Image size 2346x1568; 45° FOV
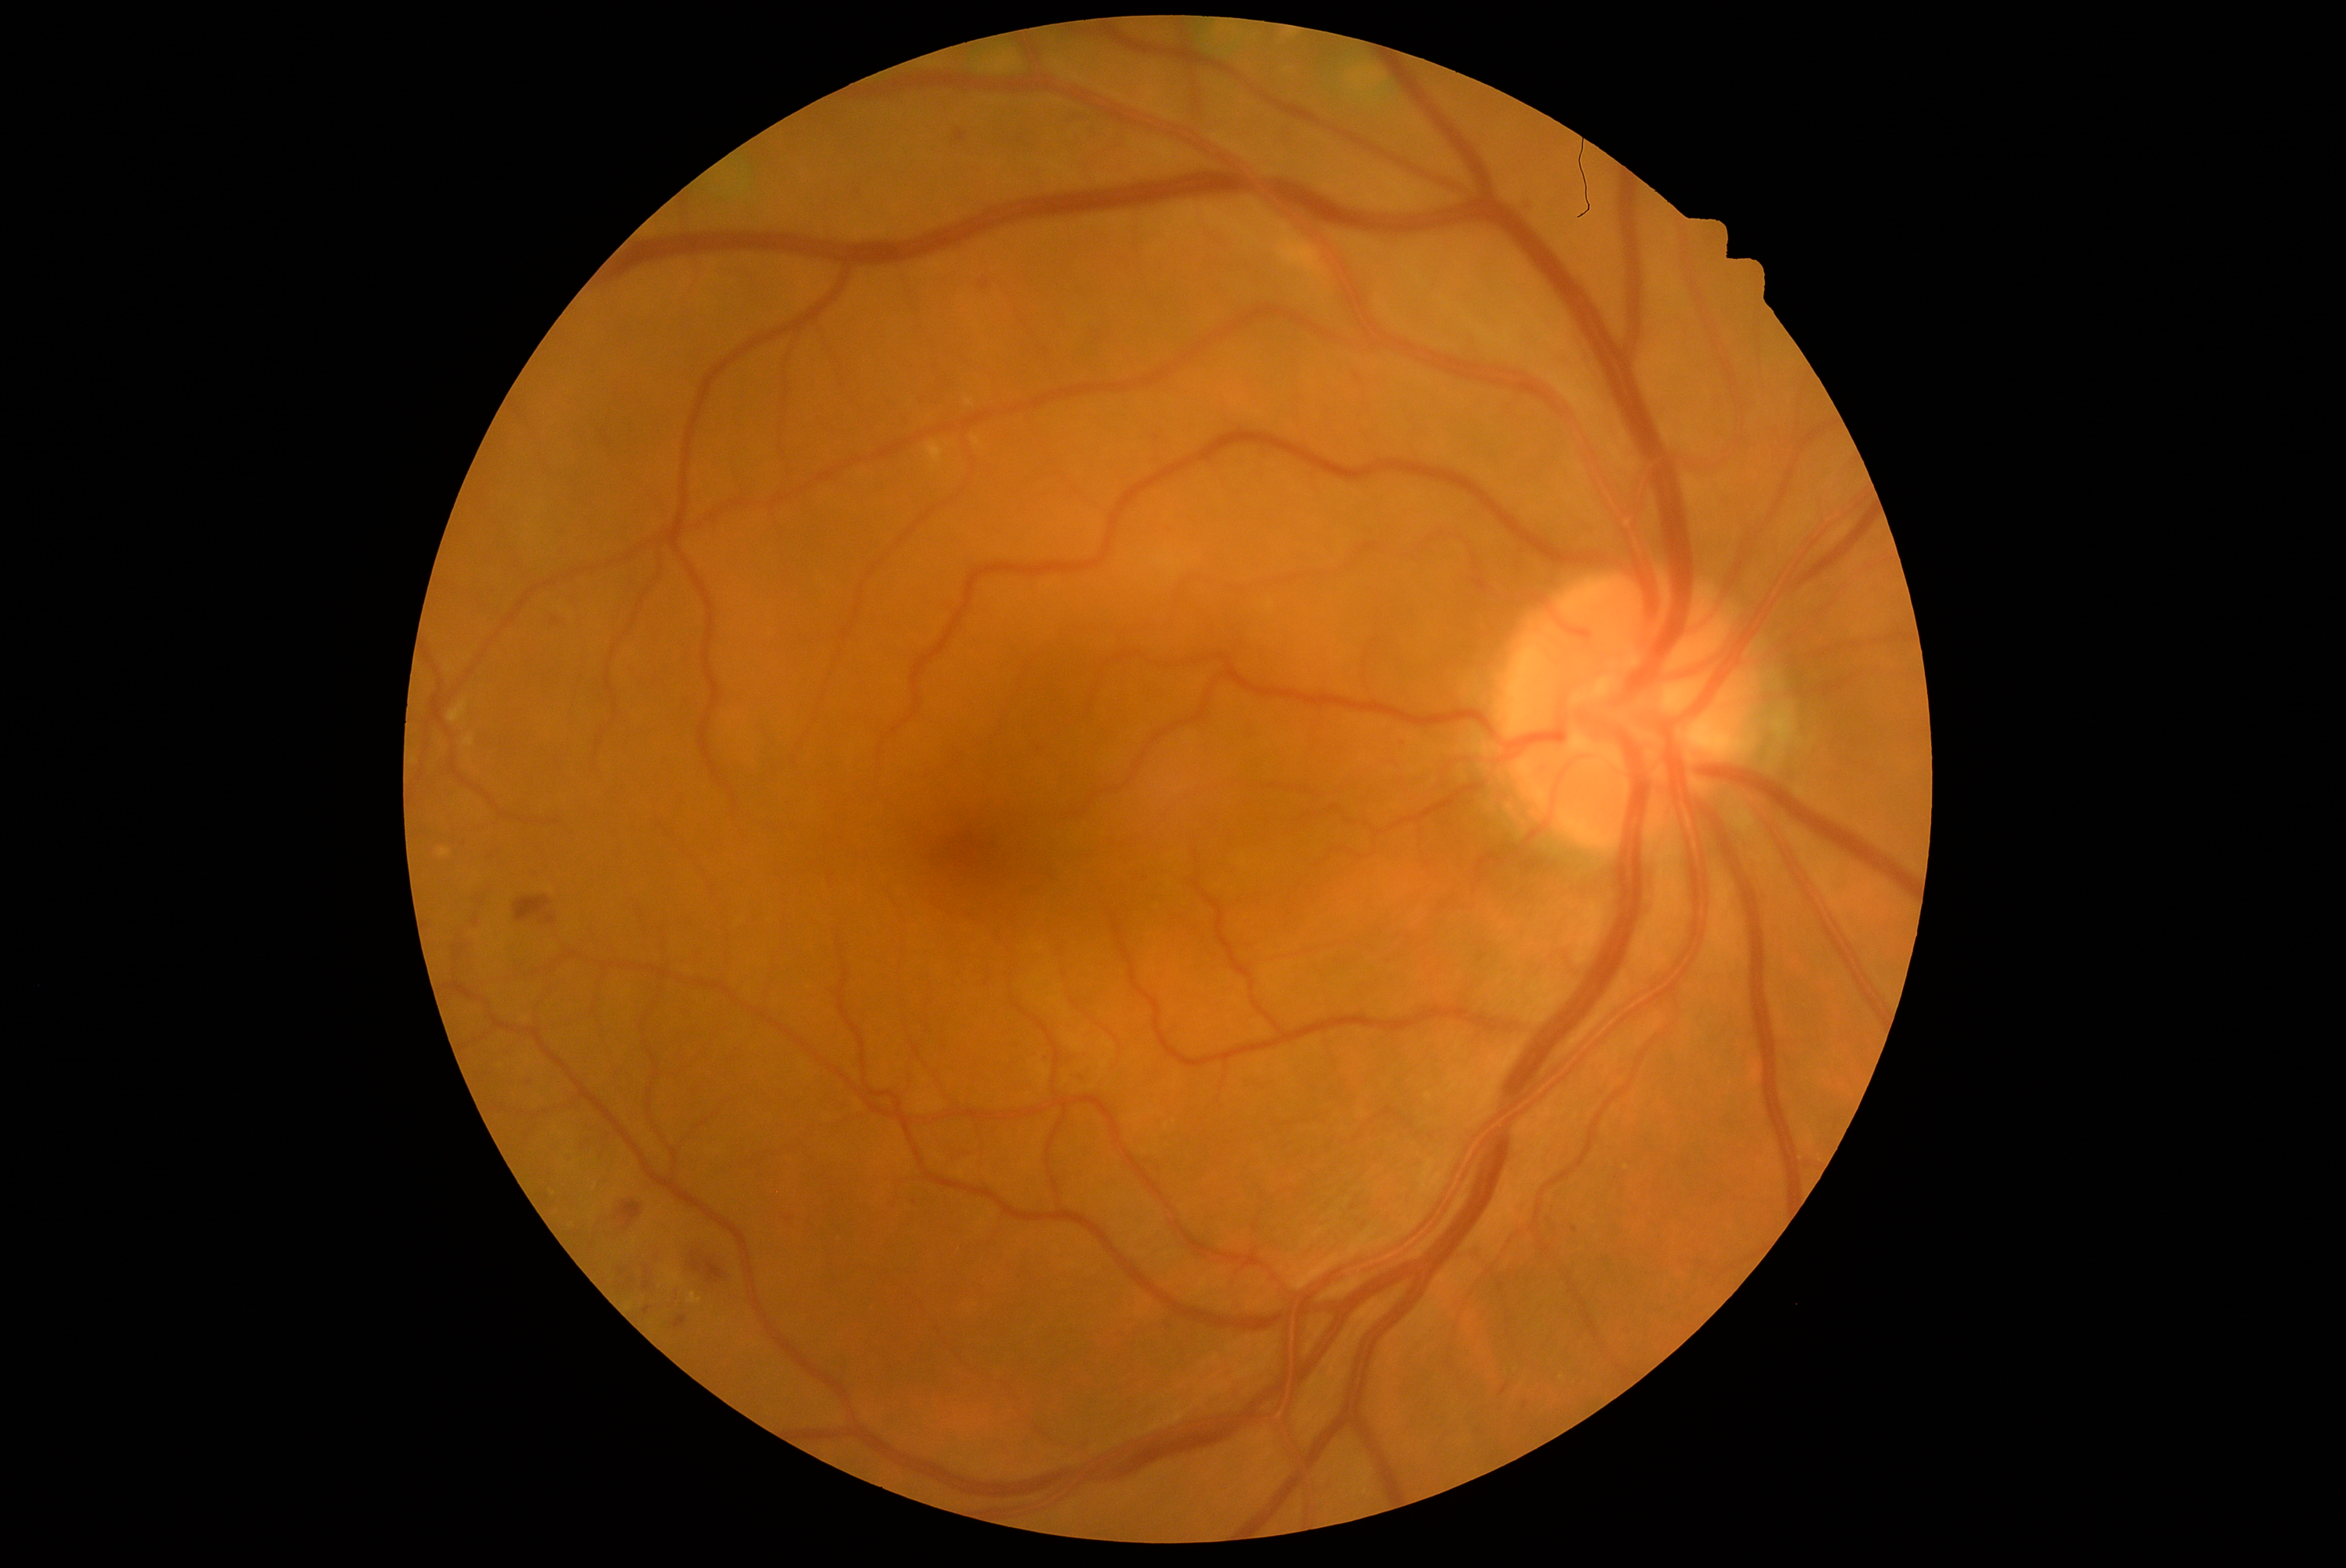 Diabetic retinopathy (DR) is grade 2
Selected lesions:
microaneurysms (MAs) (partial): region(547, 915, 556, 924), region(473, 920, 481, 927), region(644, 1307, 650, 1315), region(1528, 197, 1538, 208), region(979, 280, 990, 291), region(956, 129, 967, 143), region(595, 1153, 601, 1161)
MAs (small, approximate centers) near (646; 1273), (915; 1202), (658; 1263)